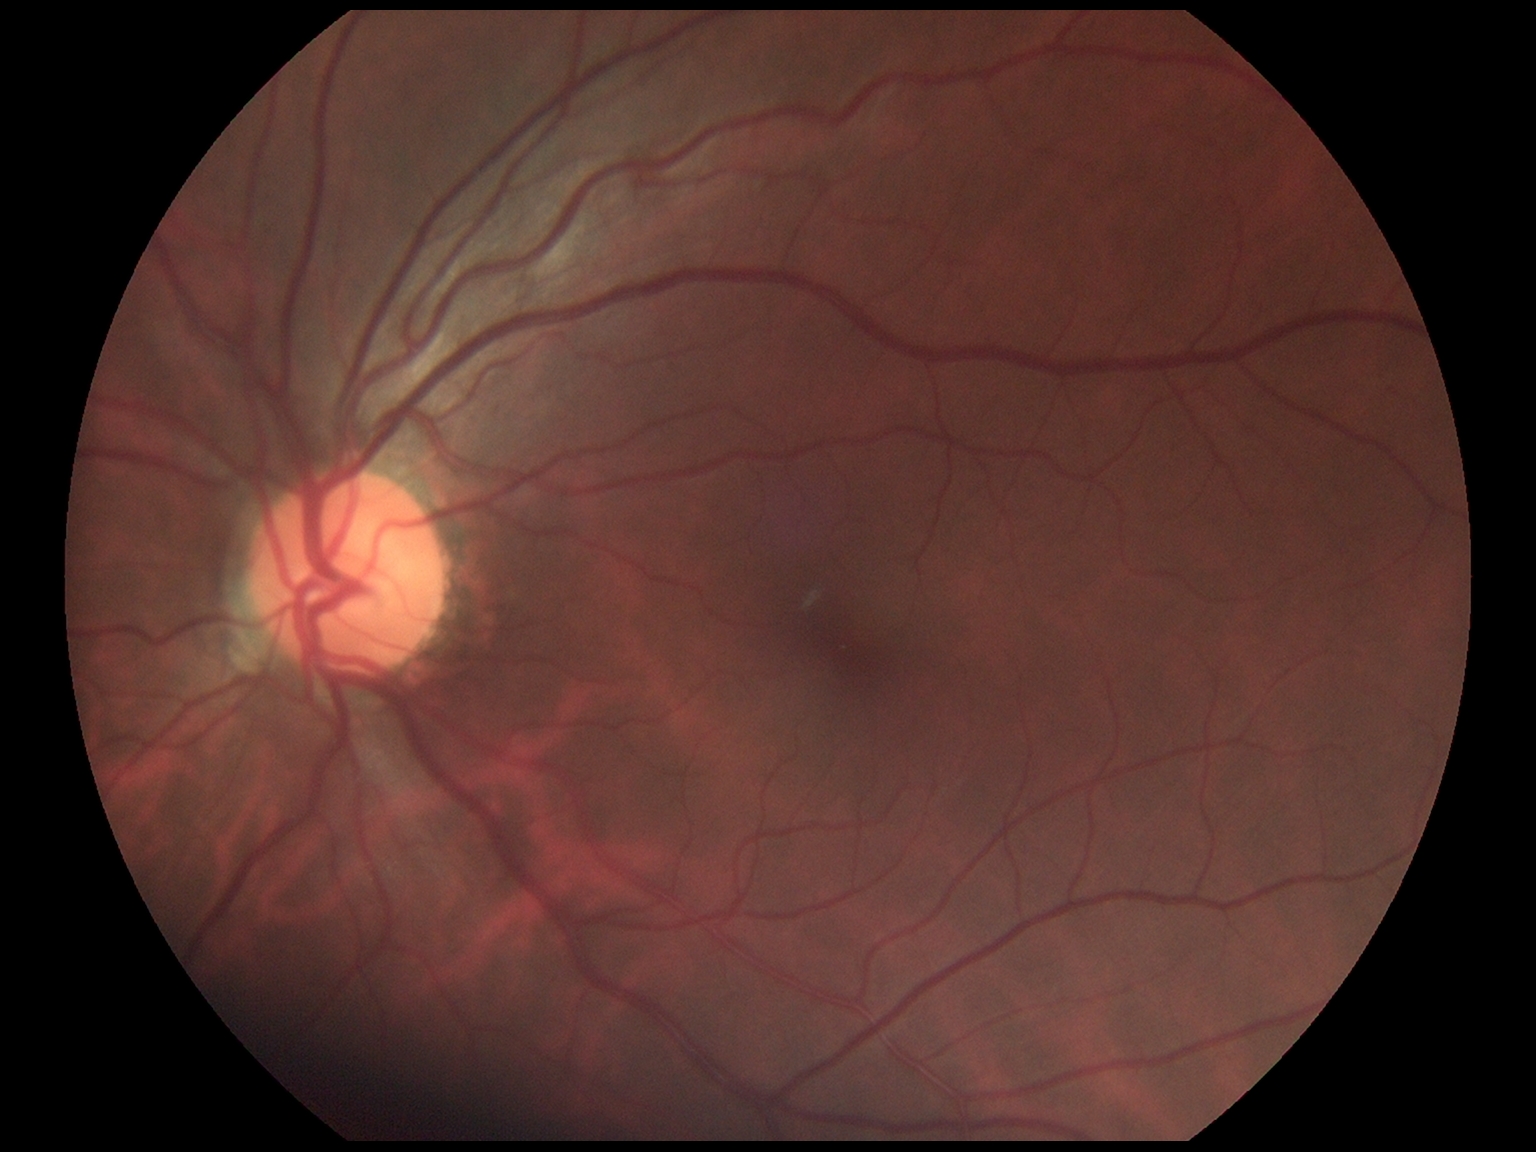

No DR findings.
Diabetic retinopathy severity is no apparent retinopathy (grade 0).